Natus RetCam Envision, 130° FOV · wide-field fundus image from infant ROP screening · 1440x1080px: 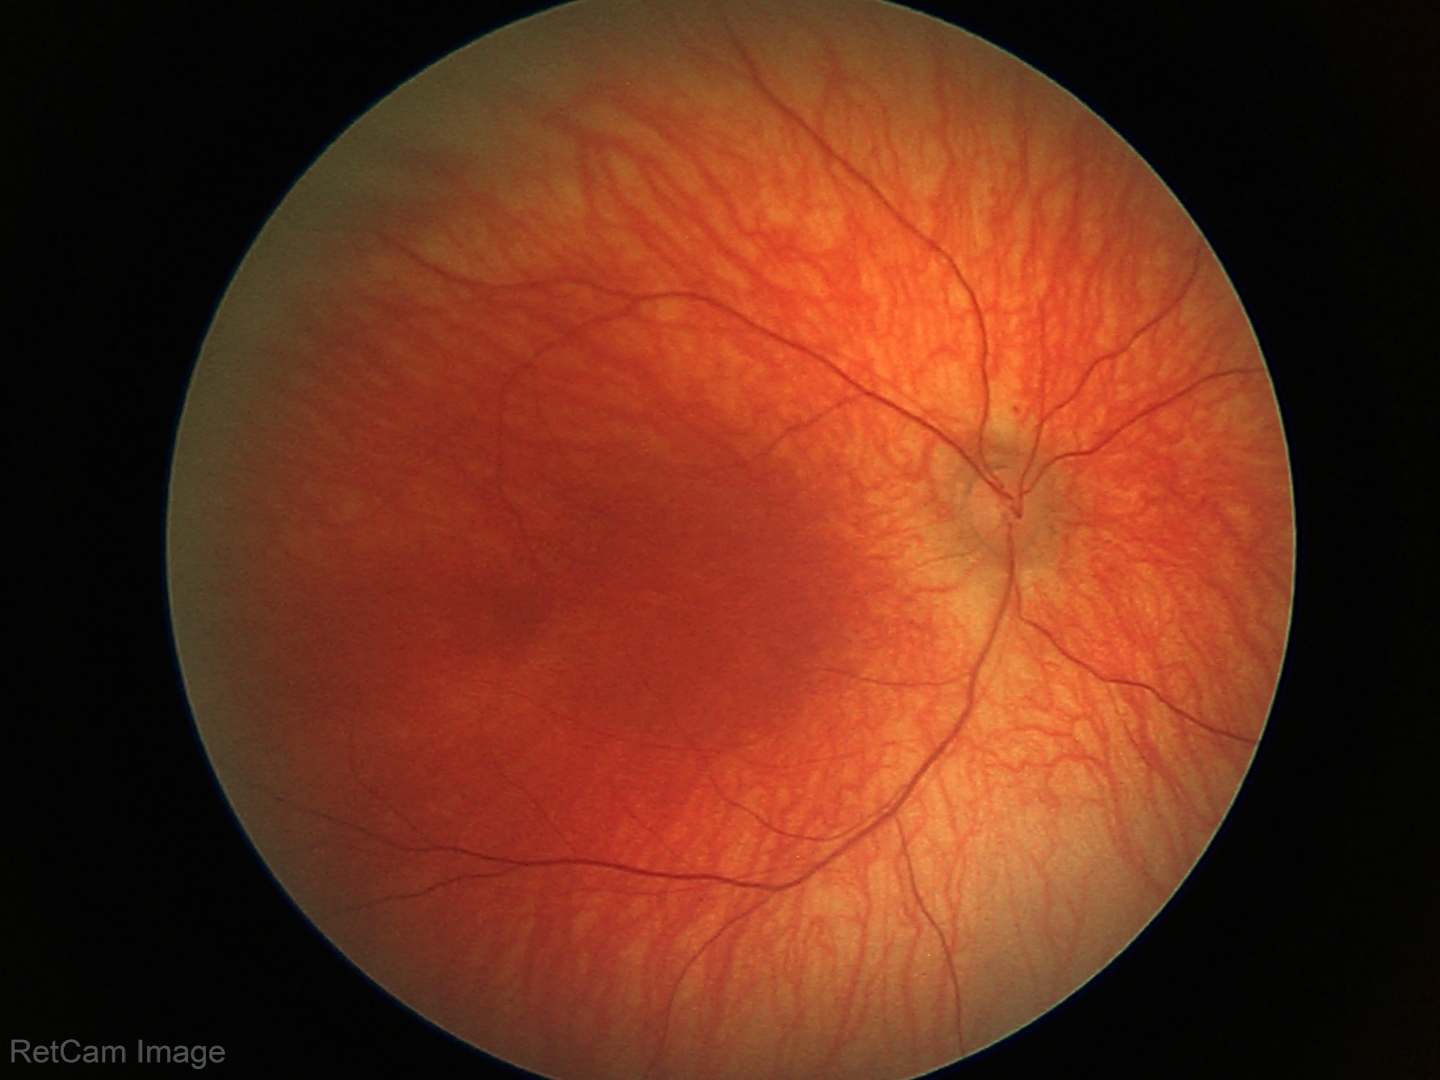

No retinal pathology identified on screening.